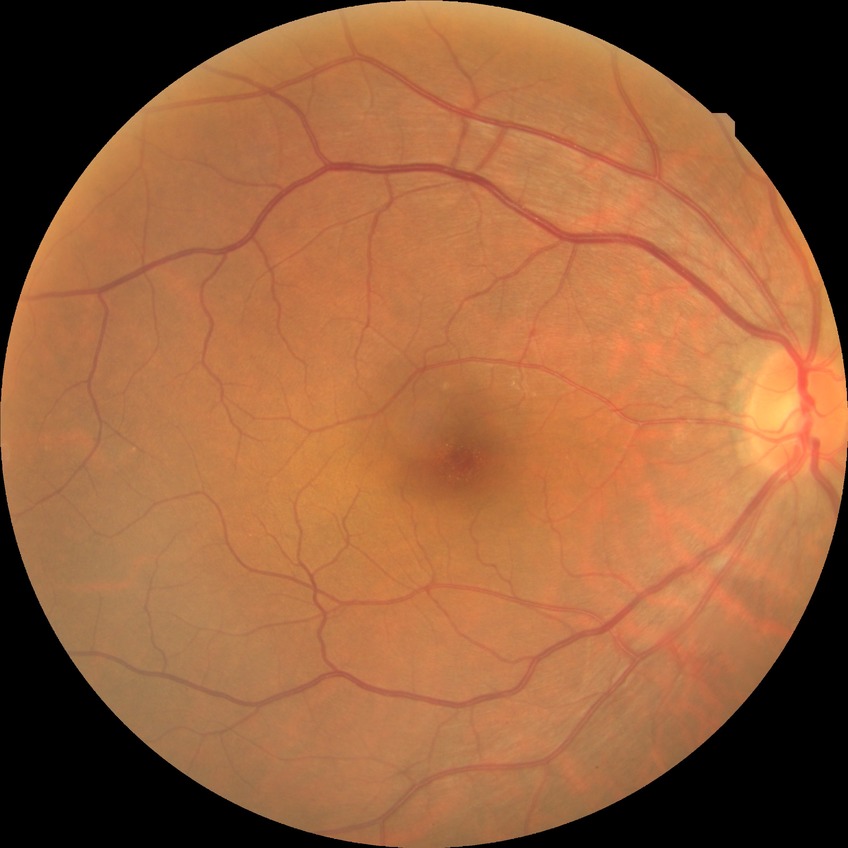 diabetic retinopathy severity@no diabetic retinopathy.